848x848
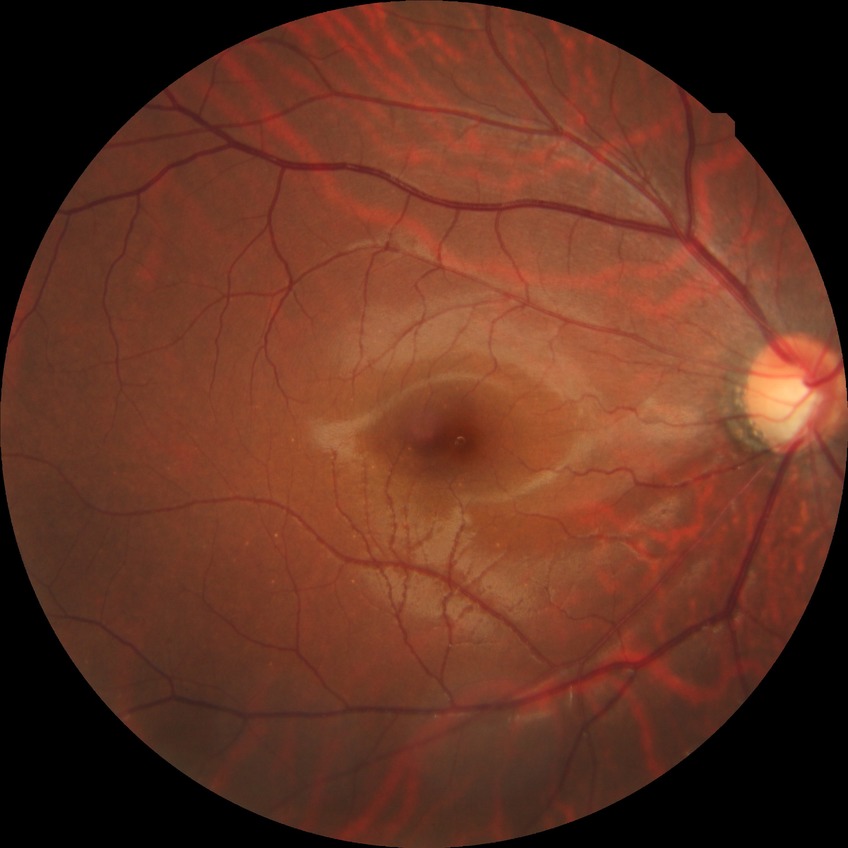
{"davis_grade": "NDR (no diabetic retinopathy)"}